Image size 1932x1932
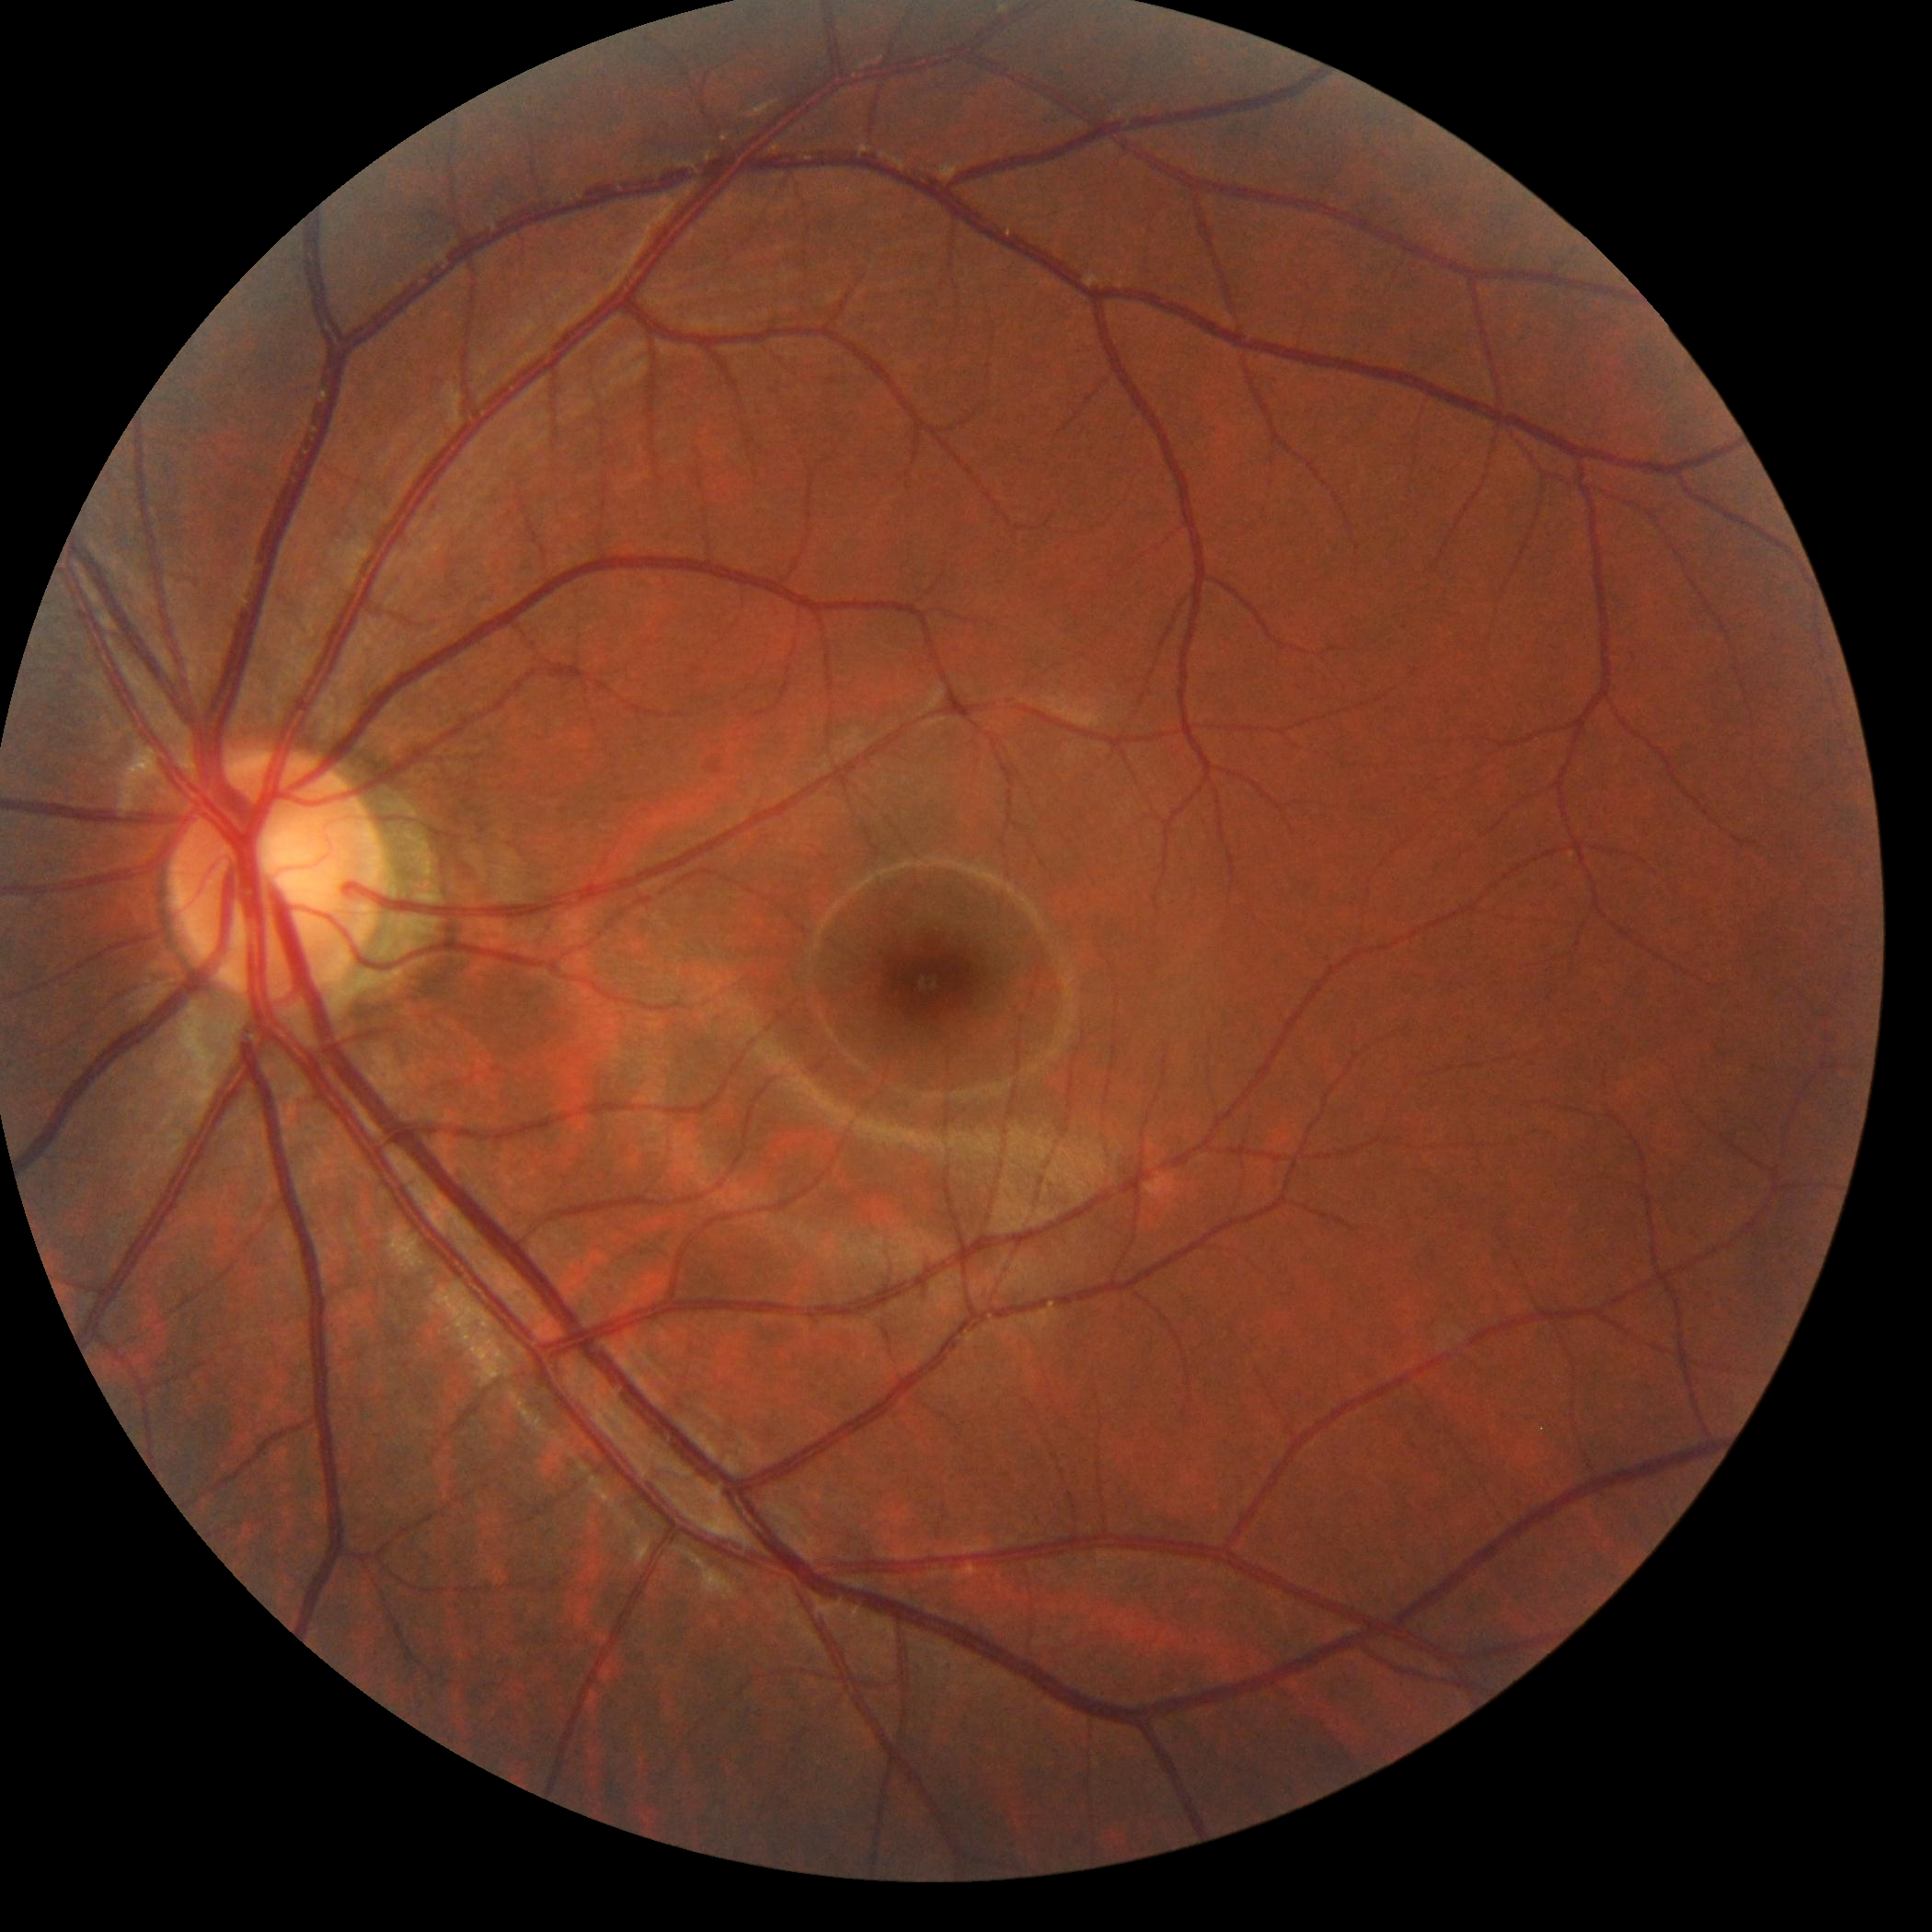
dr_grade: grade 0